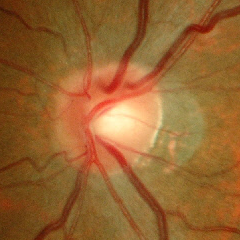

Findings consistent with early glaucomatous optic neuropathy.